Graded on the modified Davis scale; 848 by 848 pixels:
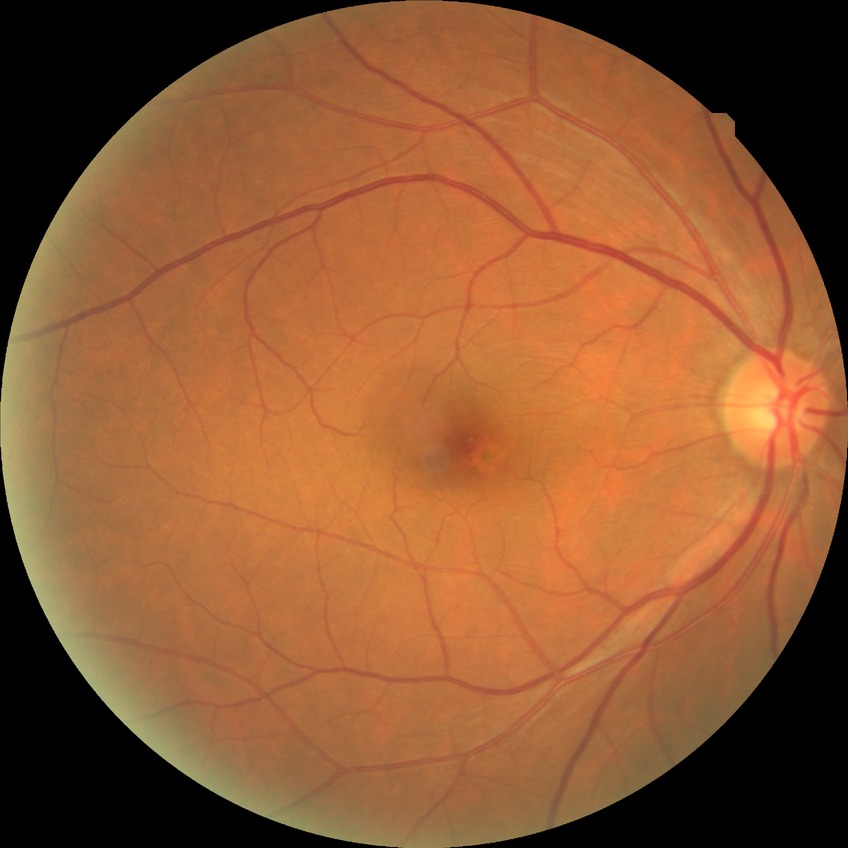 Davis grading is no diabetic retinopathy.